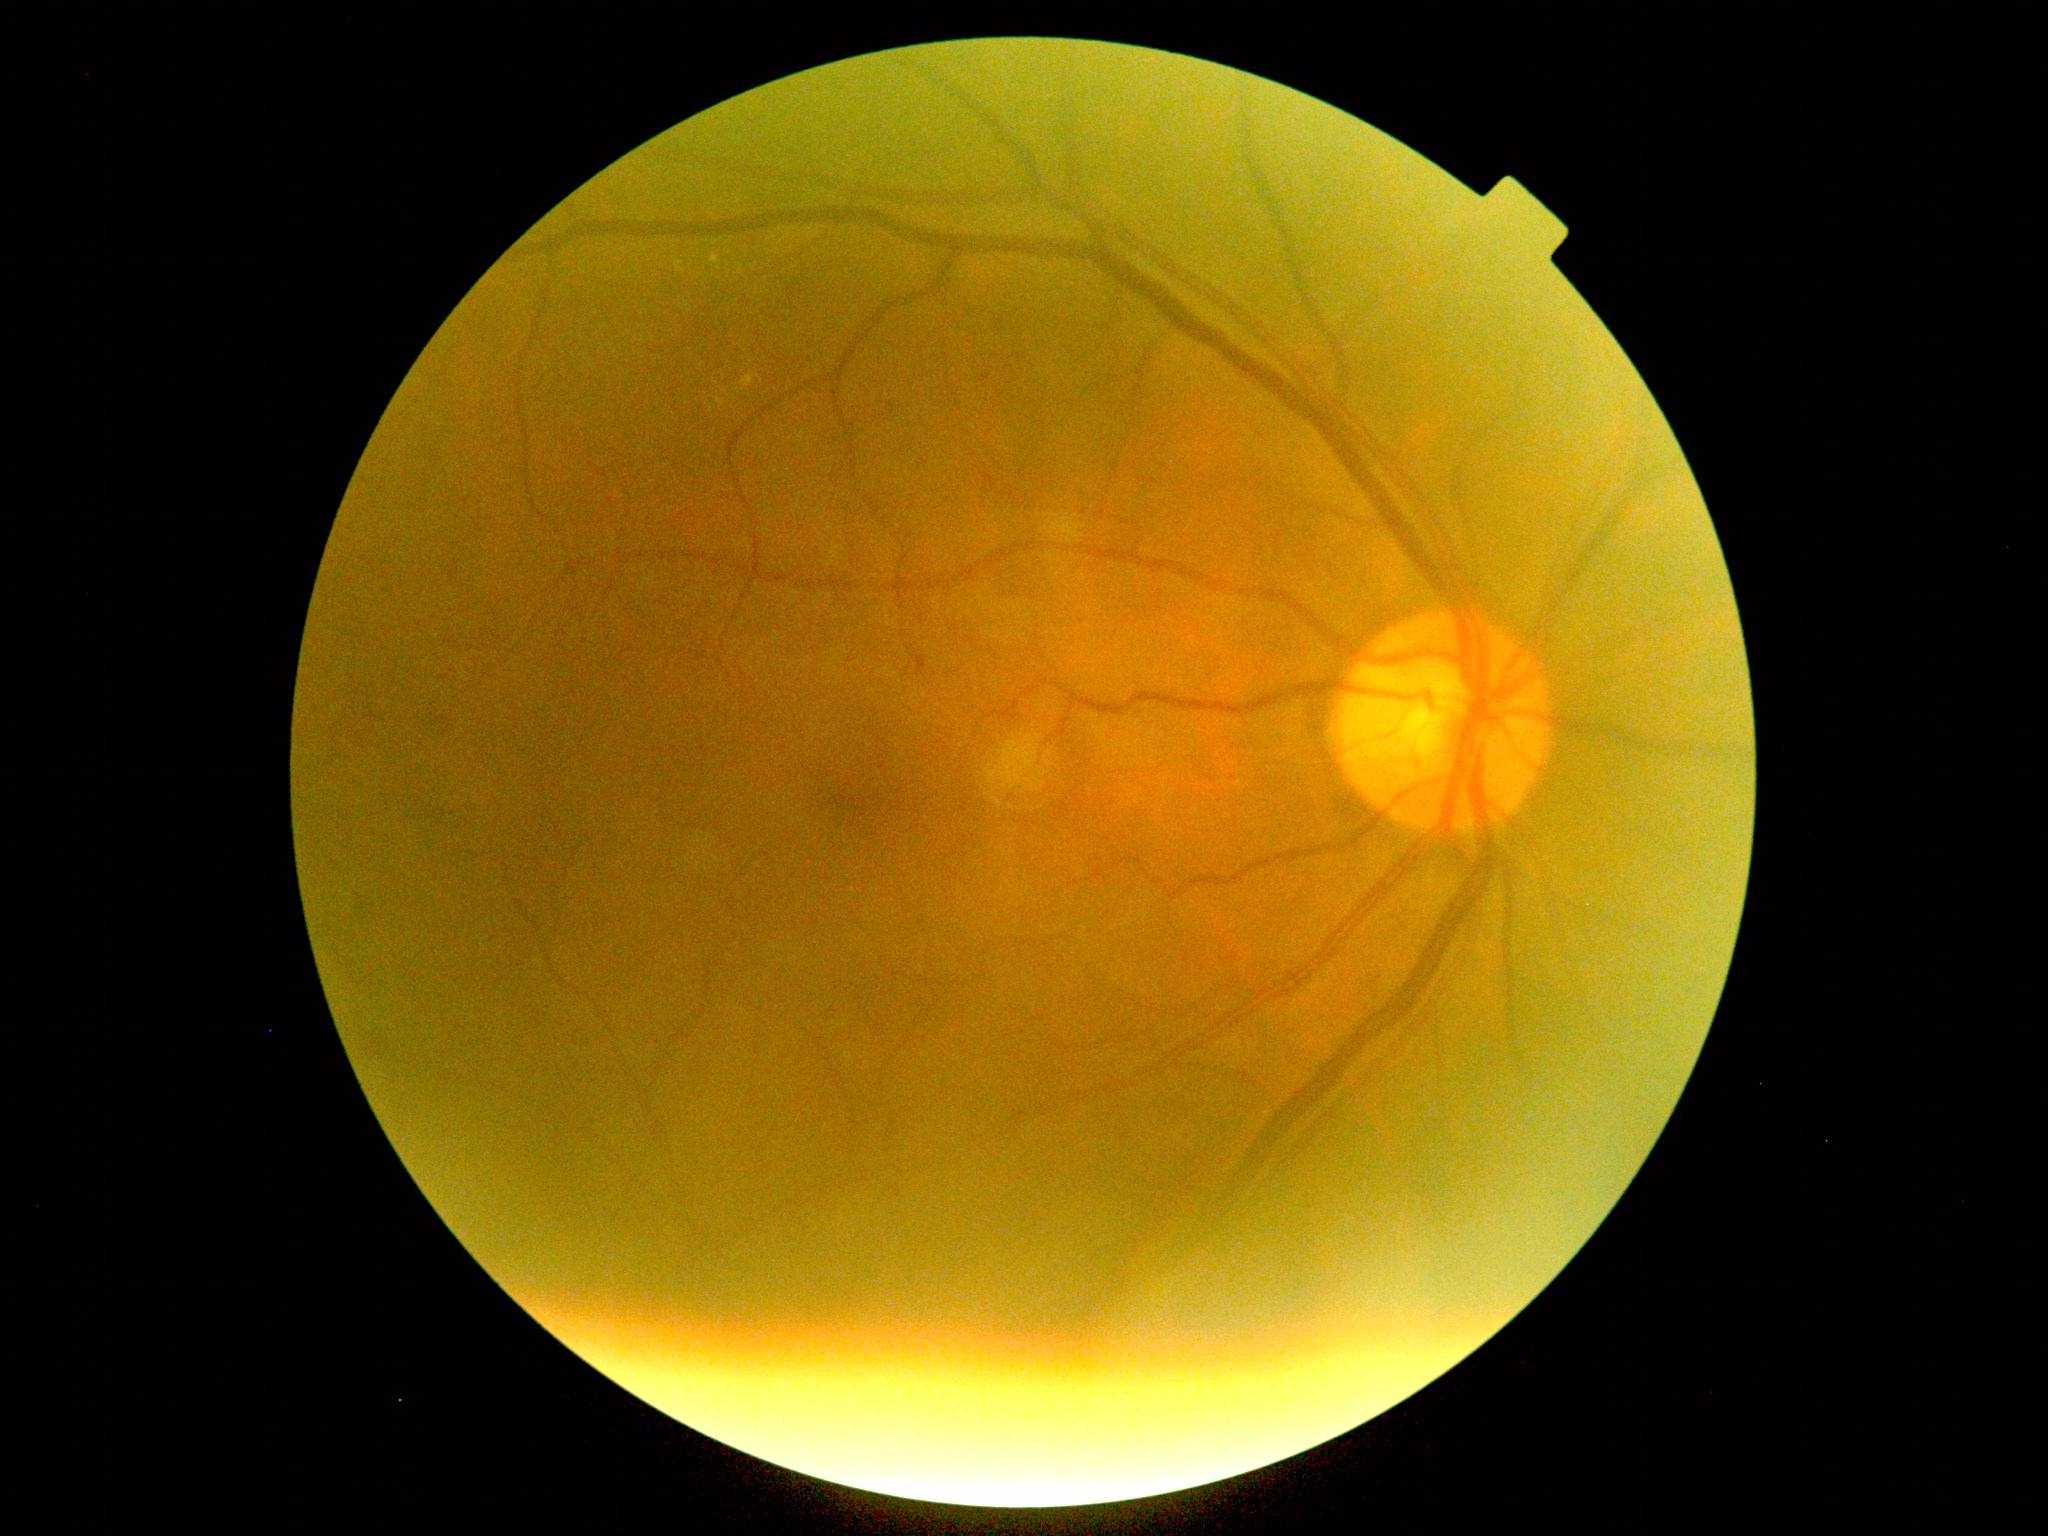

DR grade: moderate non-proliferative diabetic retinopathy (2).